Infant wide-field retinal image: 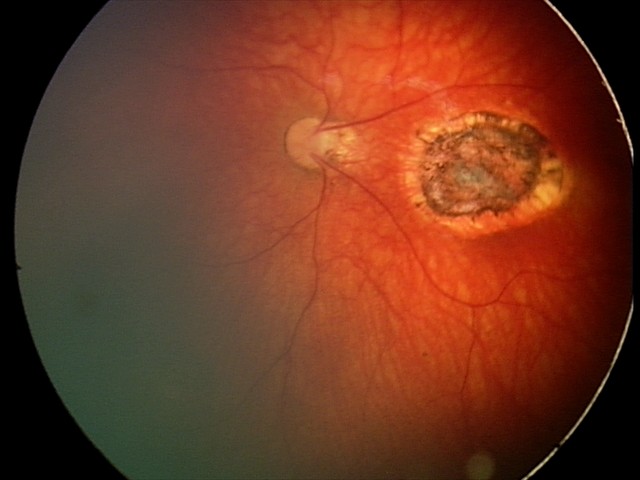 From an examination with diagnosis of toxoplasmosis chorioretinitis.